Retinal fundus photograph; acquired with a Remidio Fundus on Phone; 1659 by 2212 pixels.
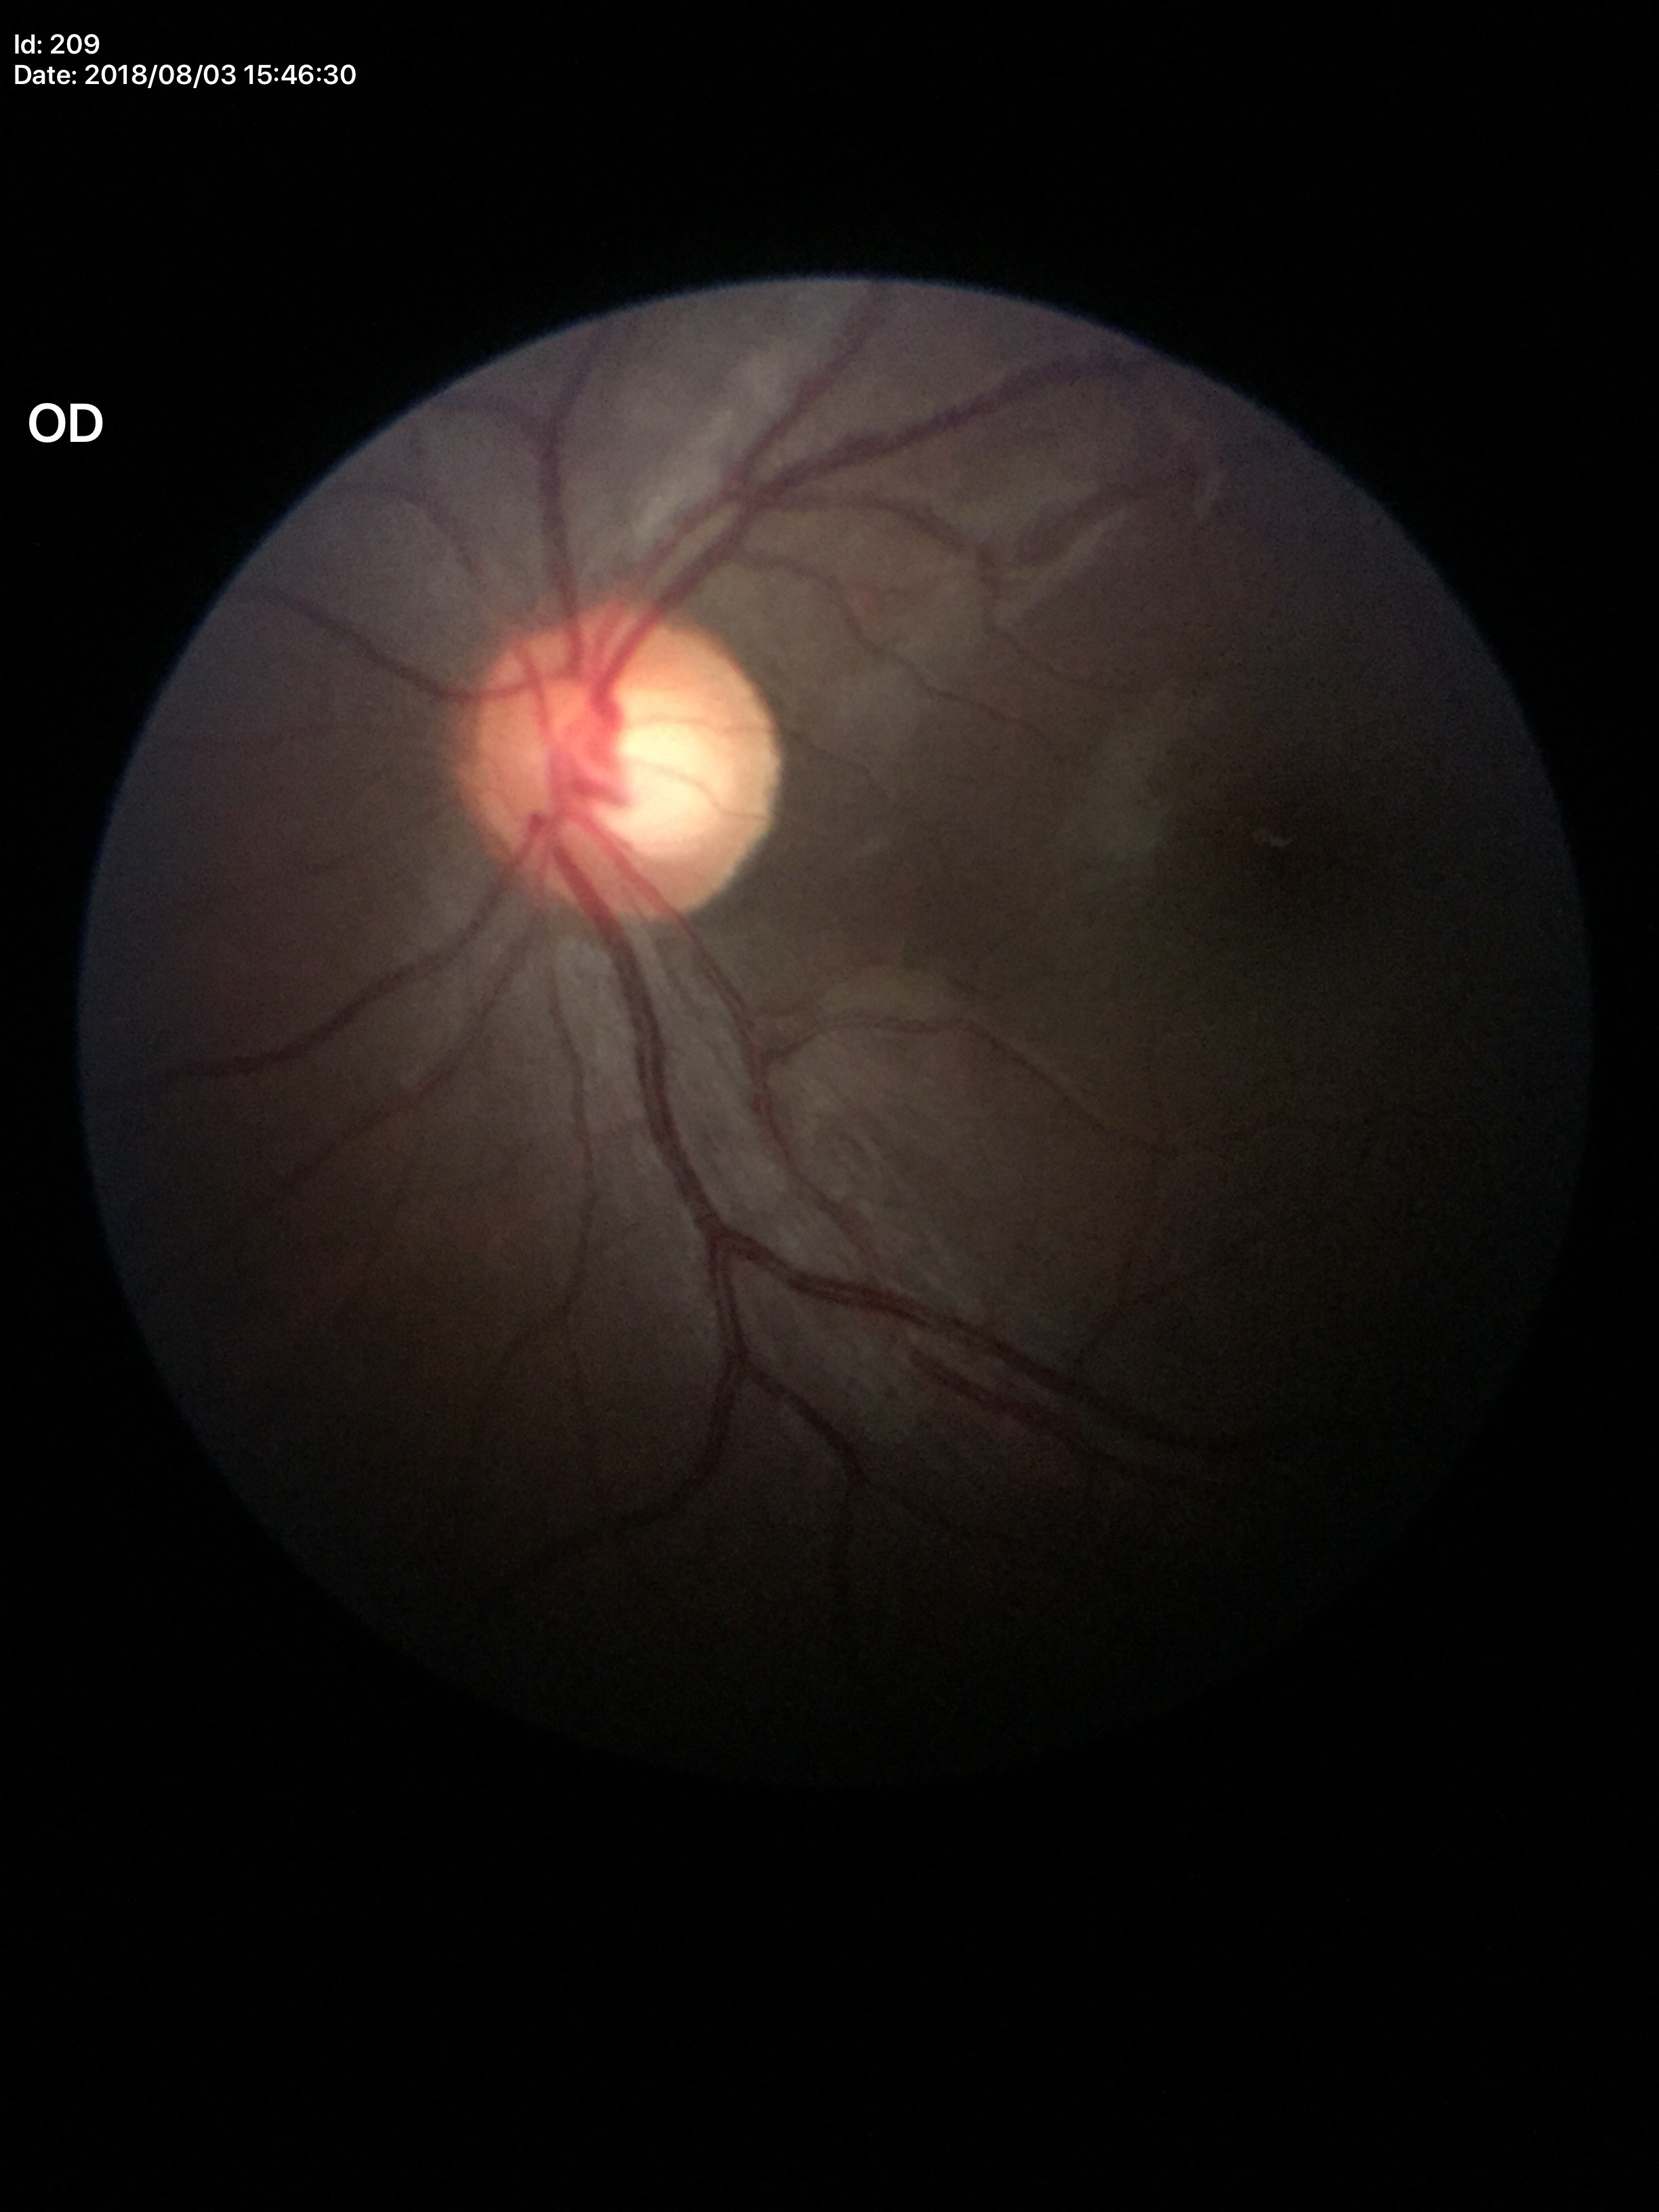

  vcdr: 0.57
  acdr: 0.34
  glaucoma_decision: negative
  hcdr: 0.60